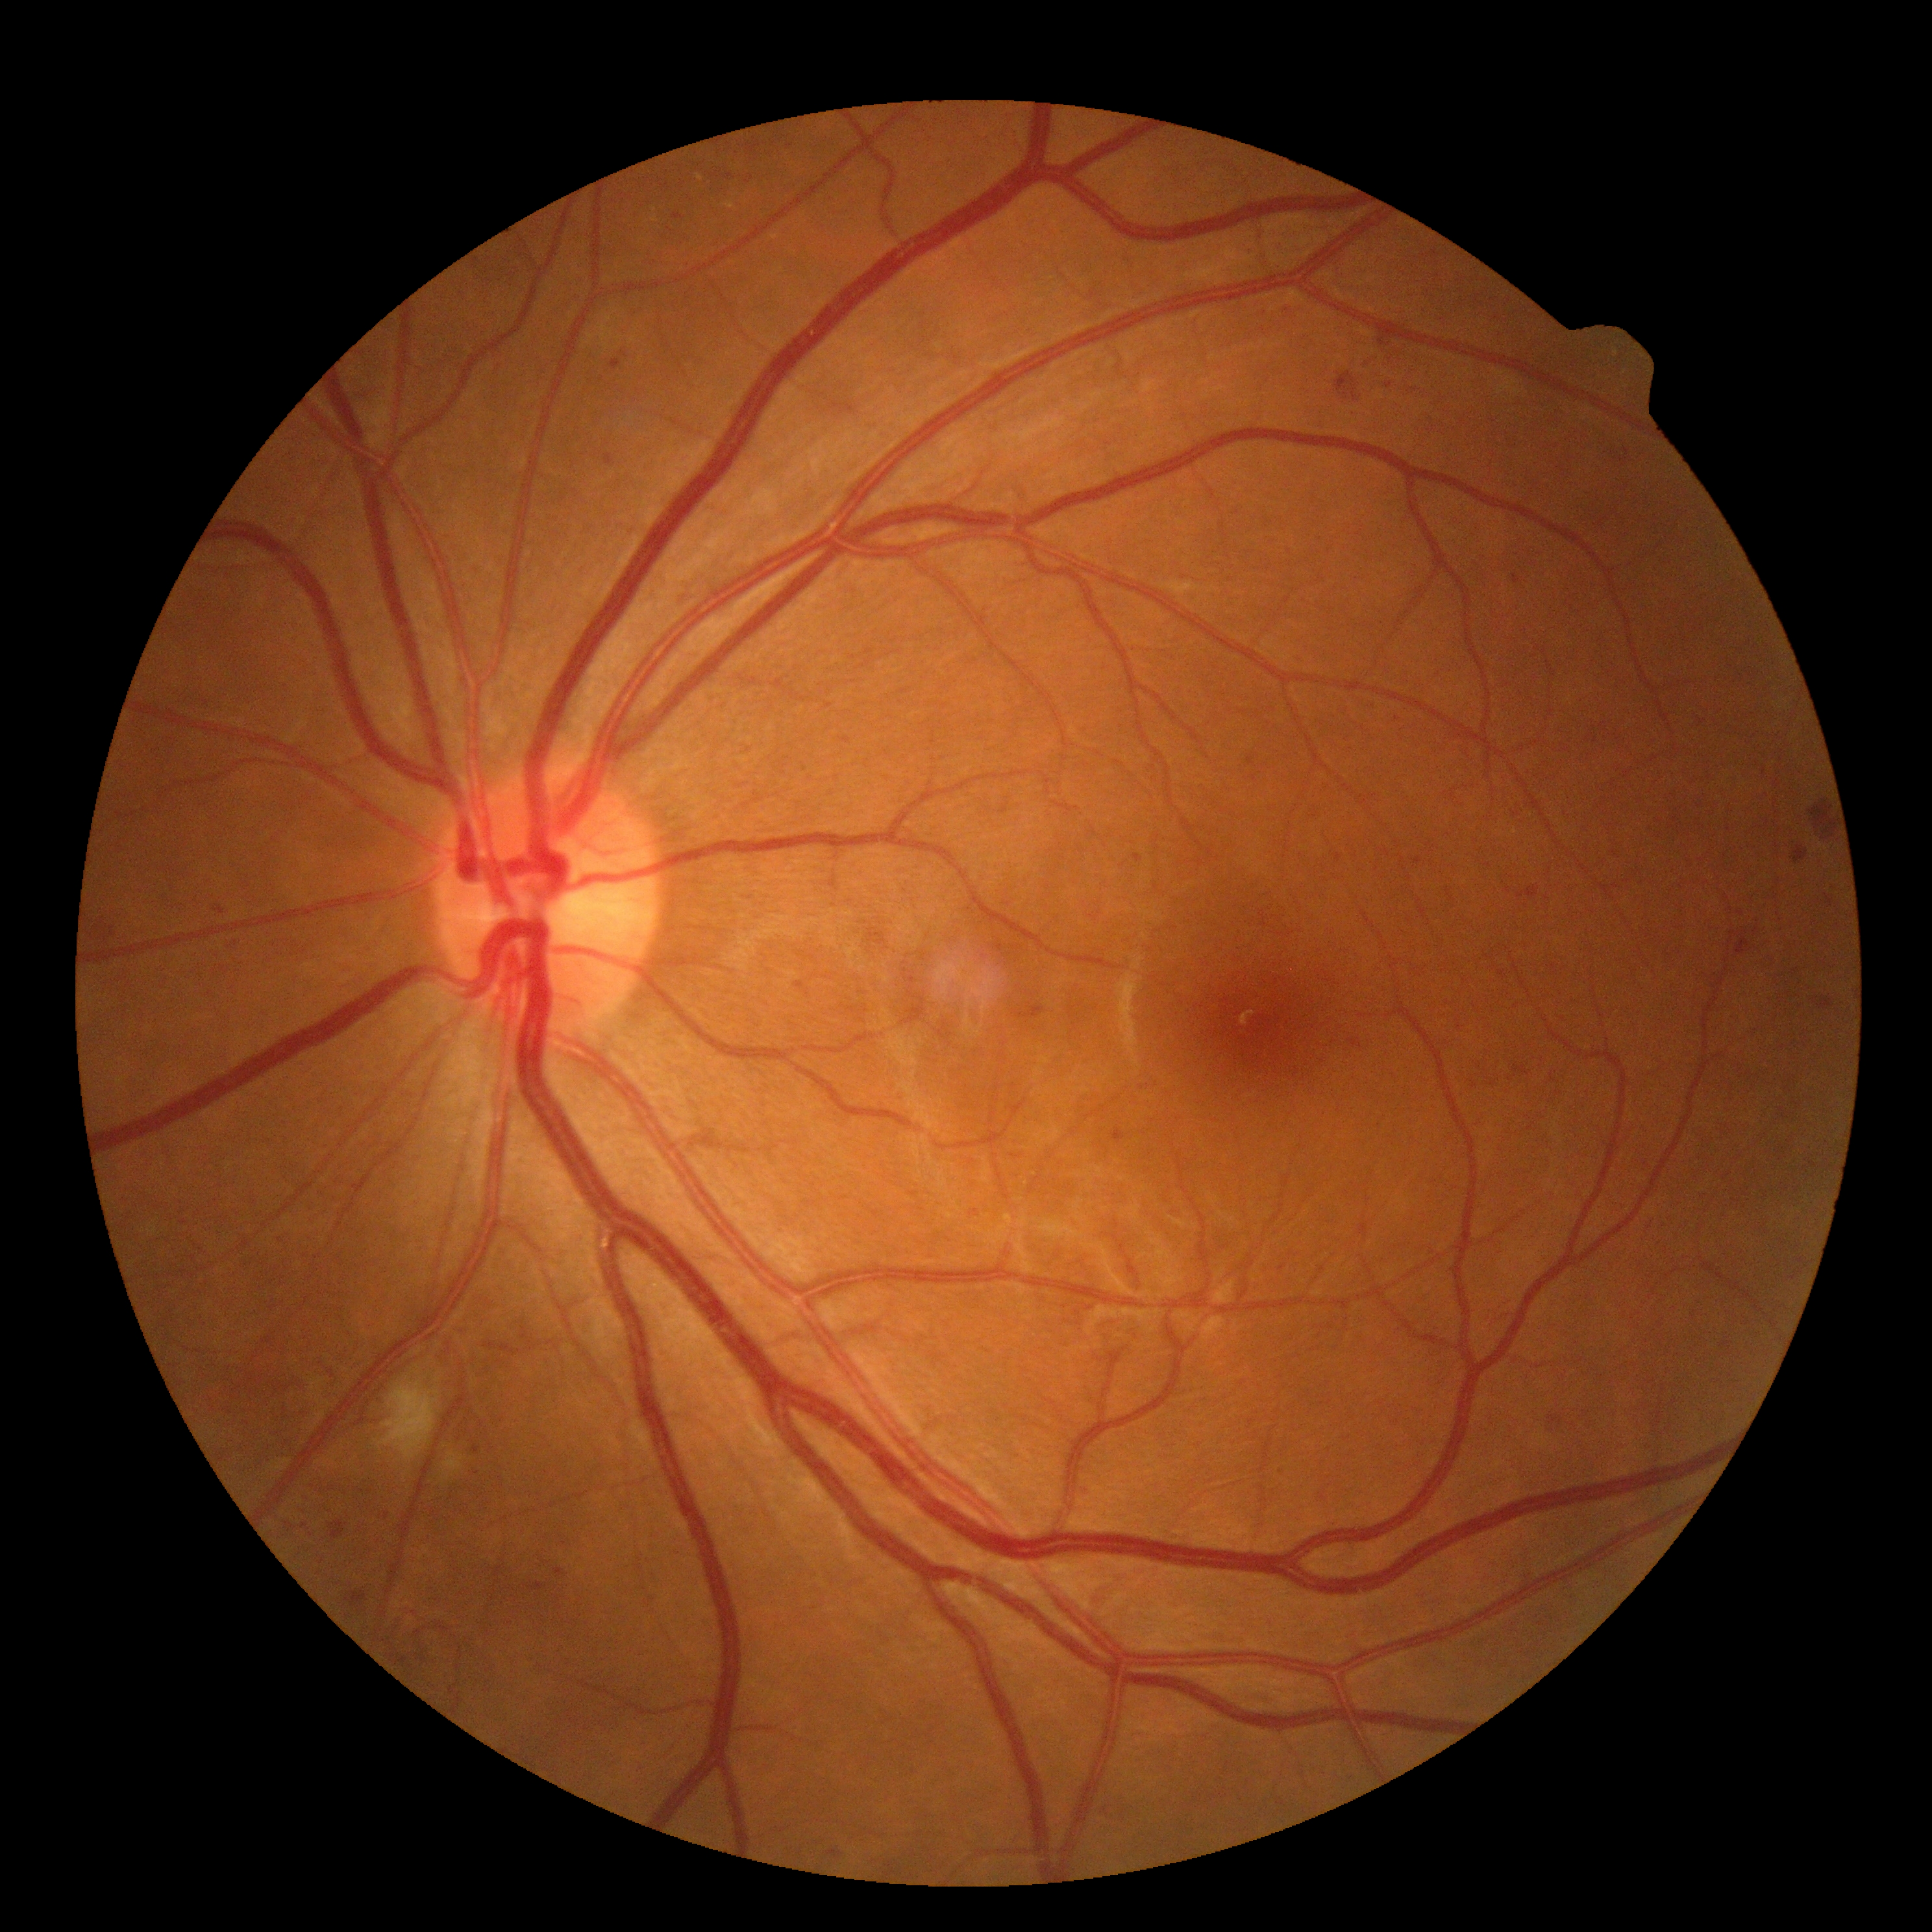 Retinopathy grade is 2 (moderate NPDR).